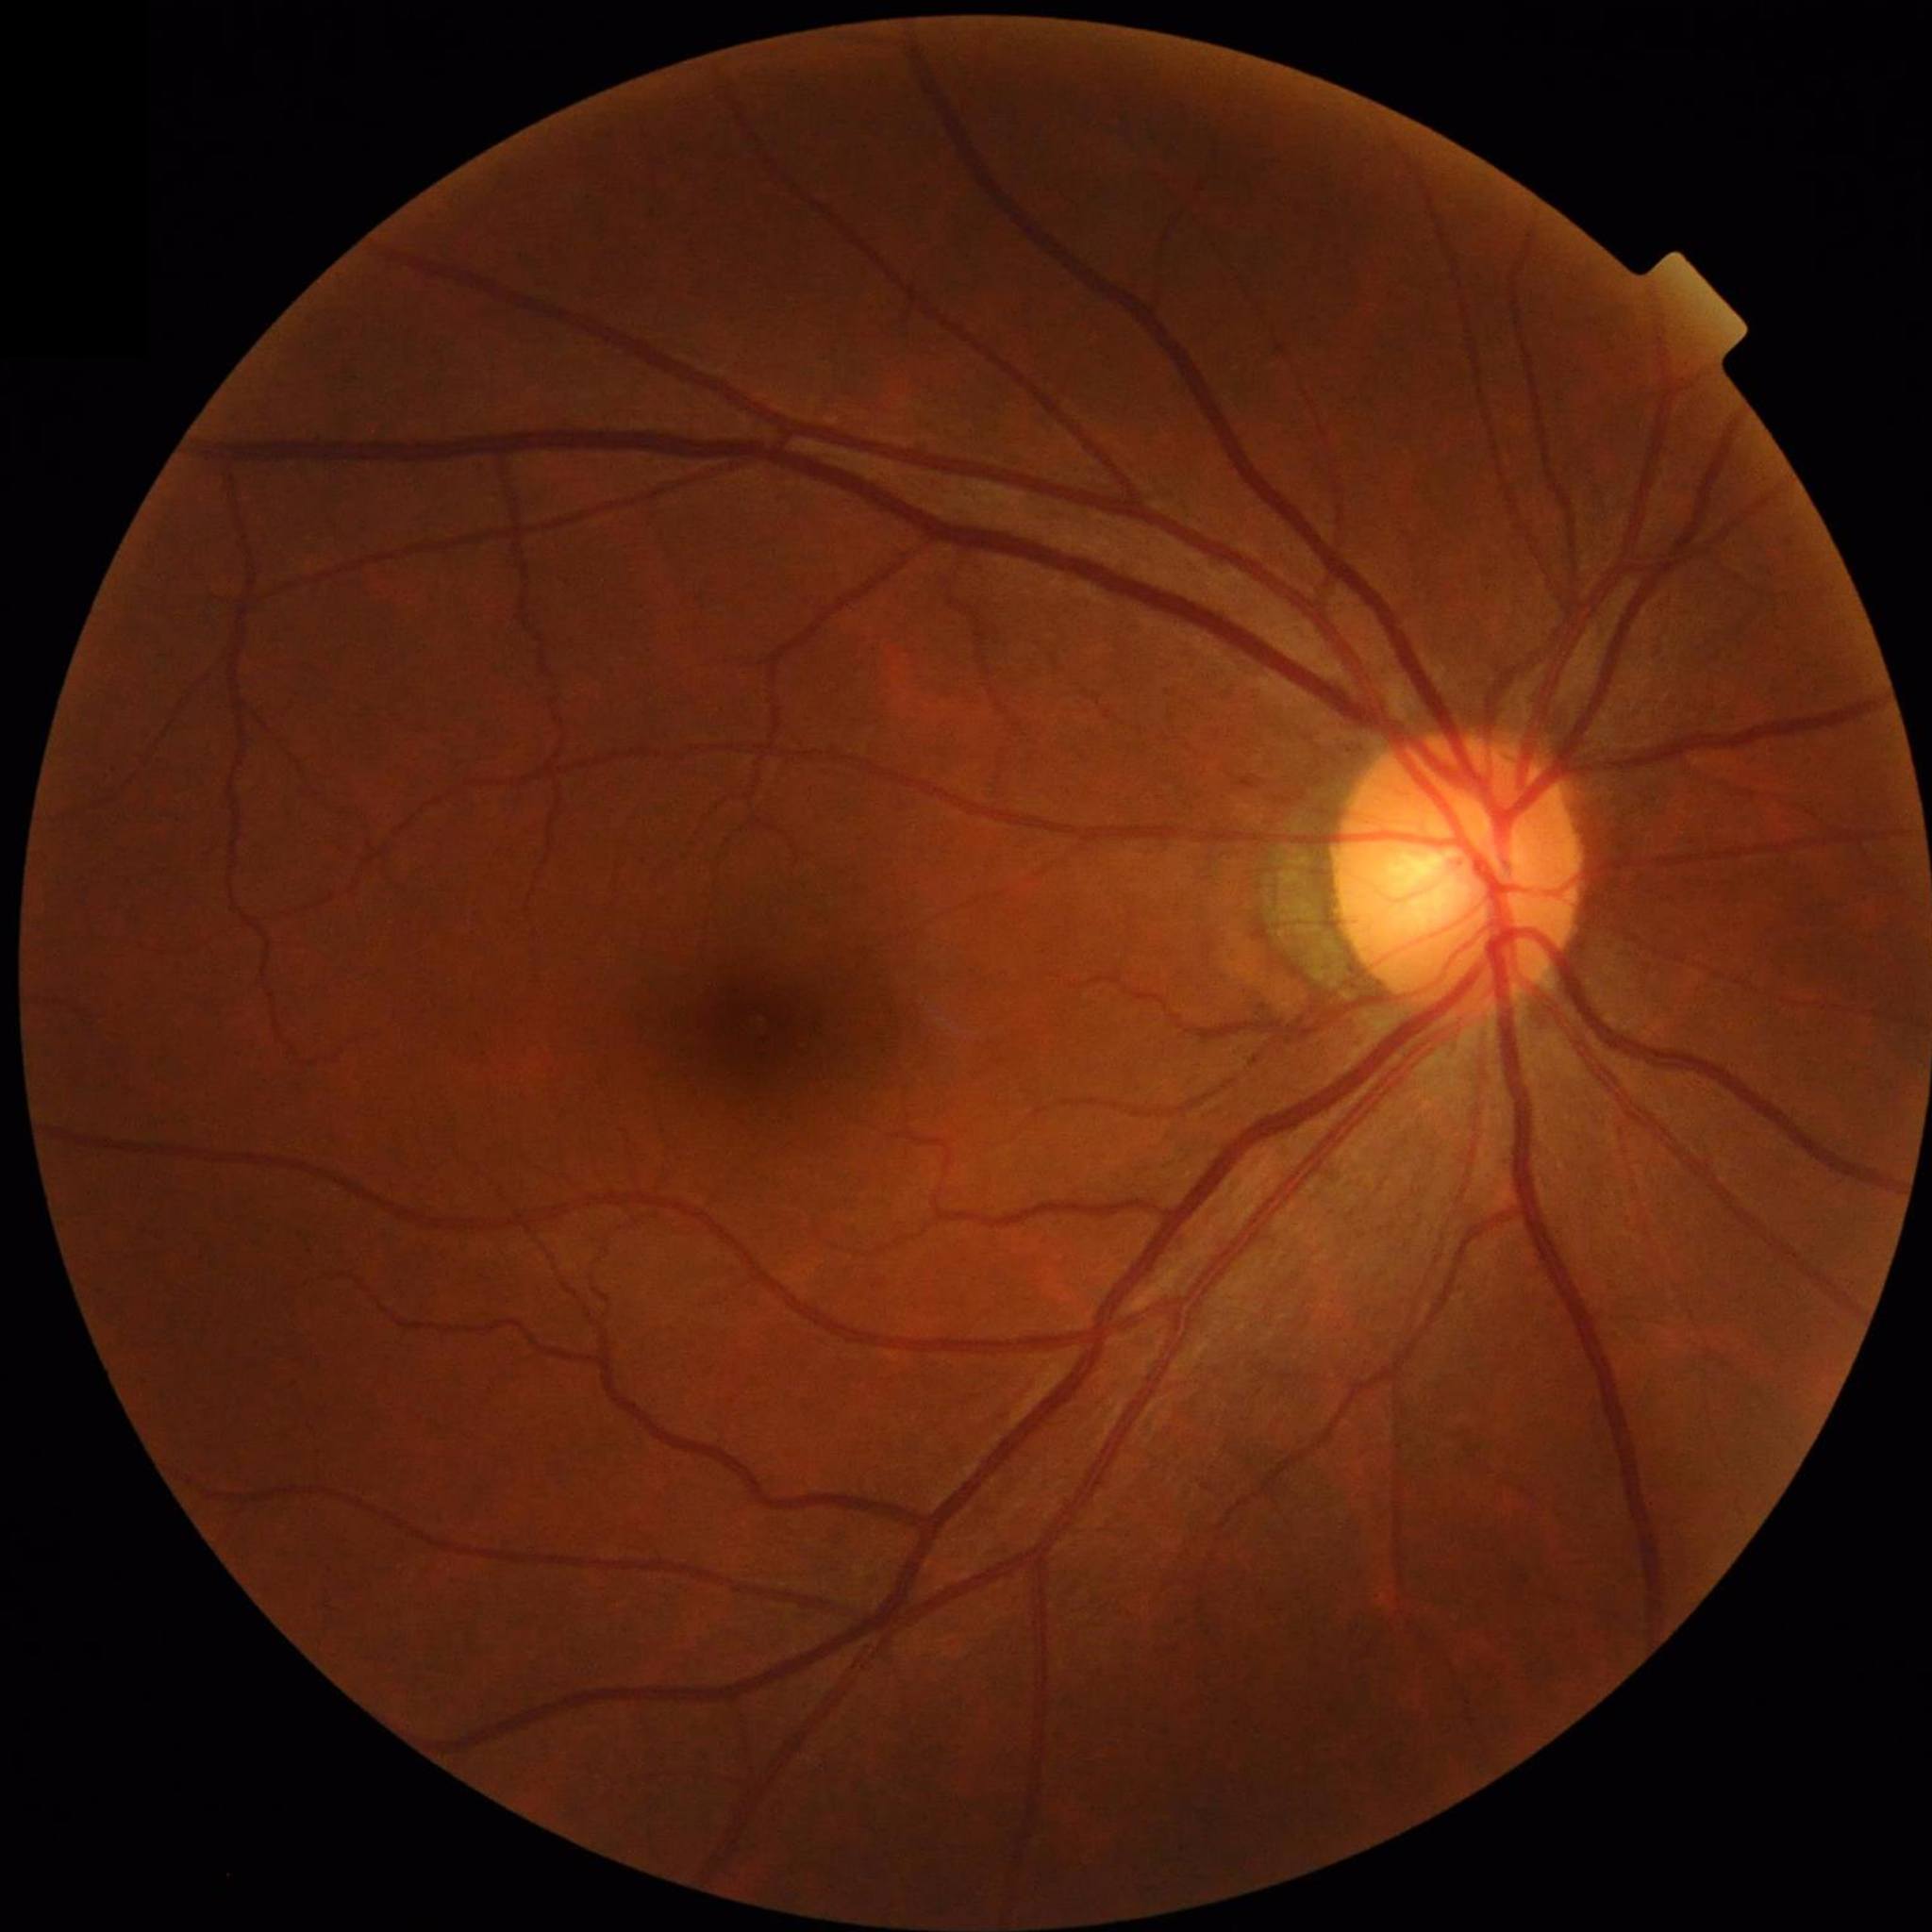

Color fundus photo from a control patient without diagnosed retinal disease.